Wide-field retinal mosaic image; image size 1924x1556
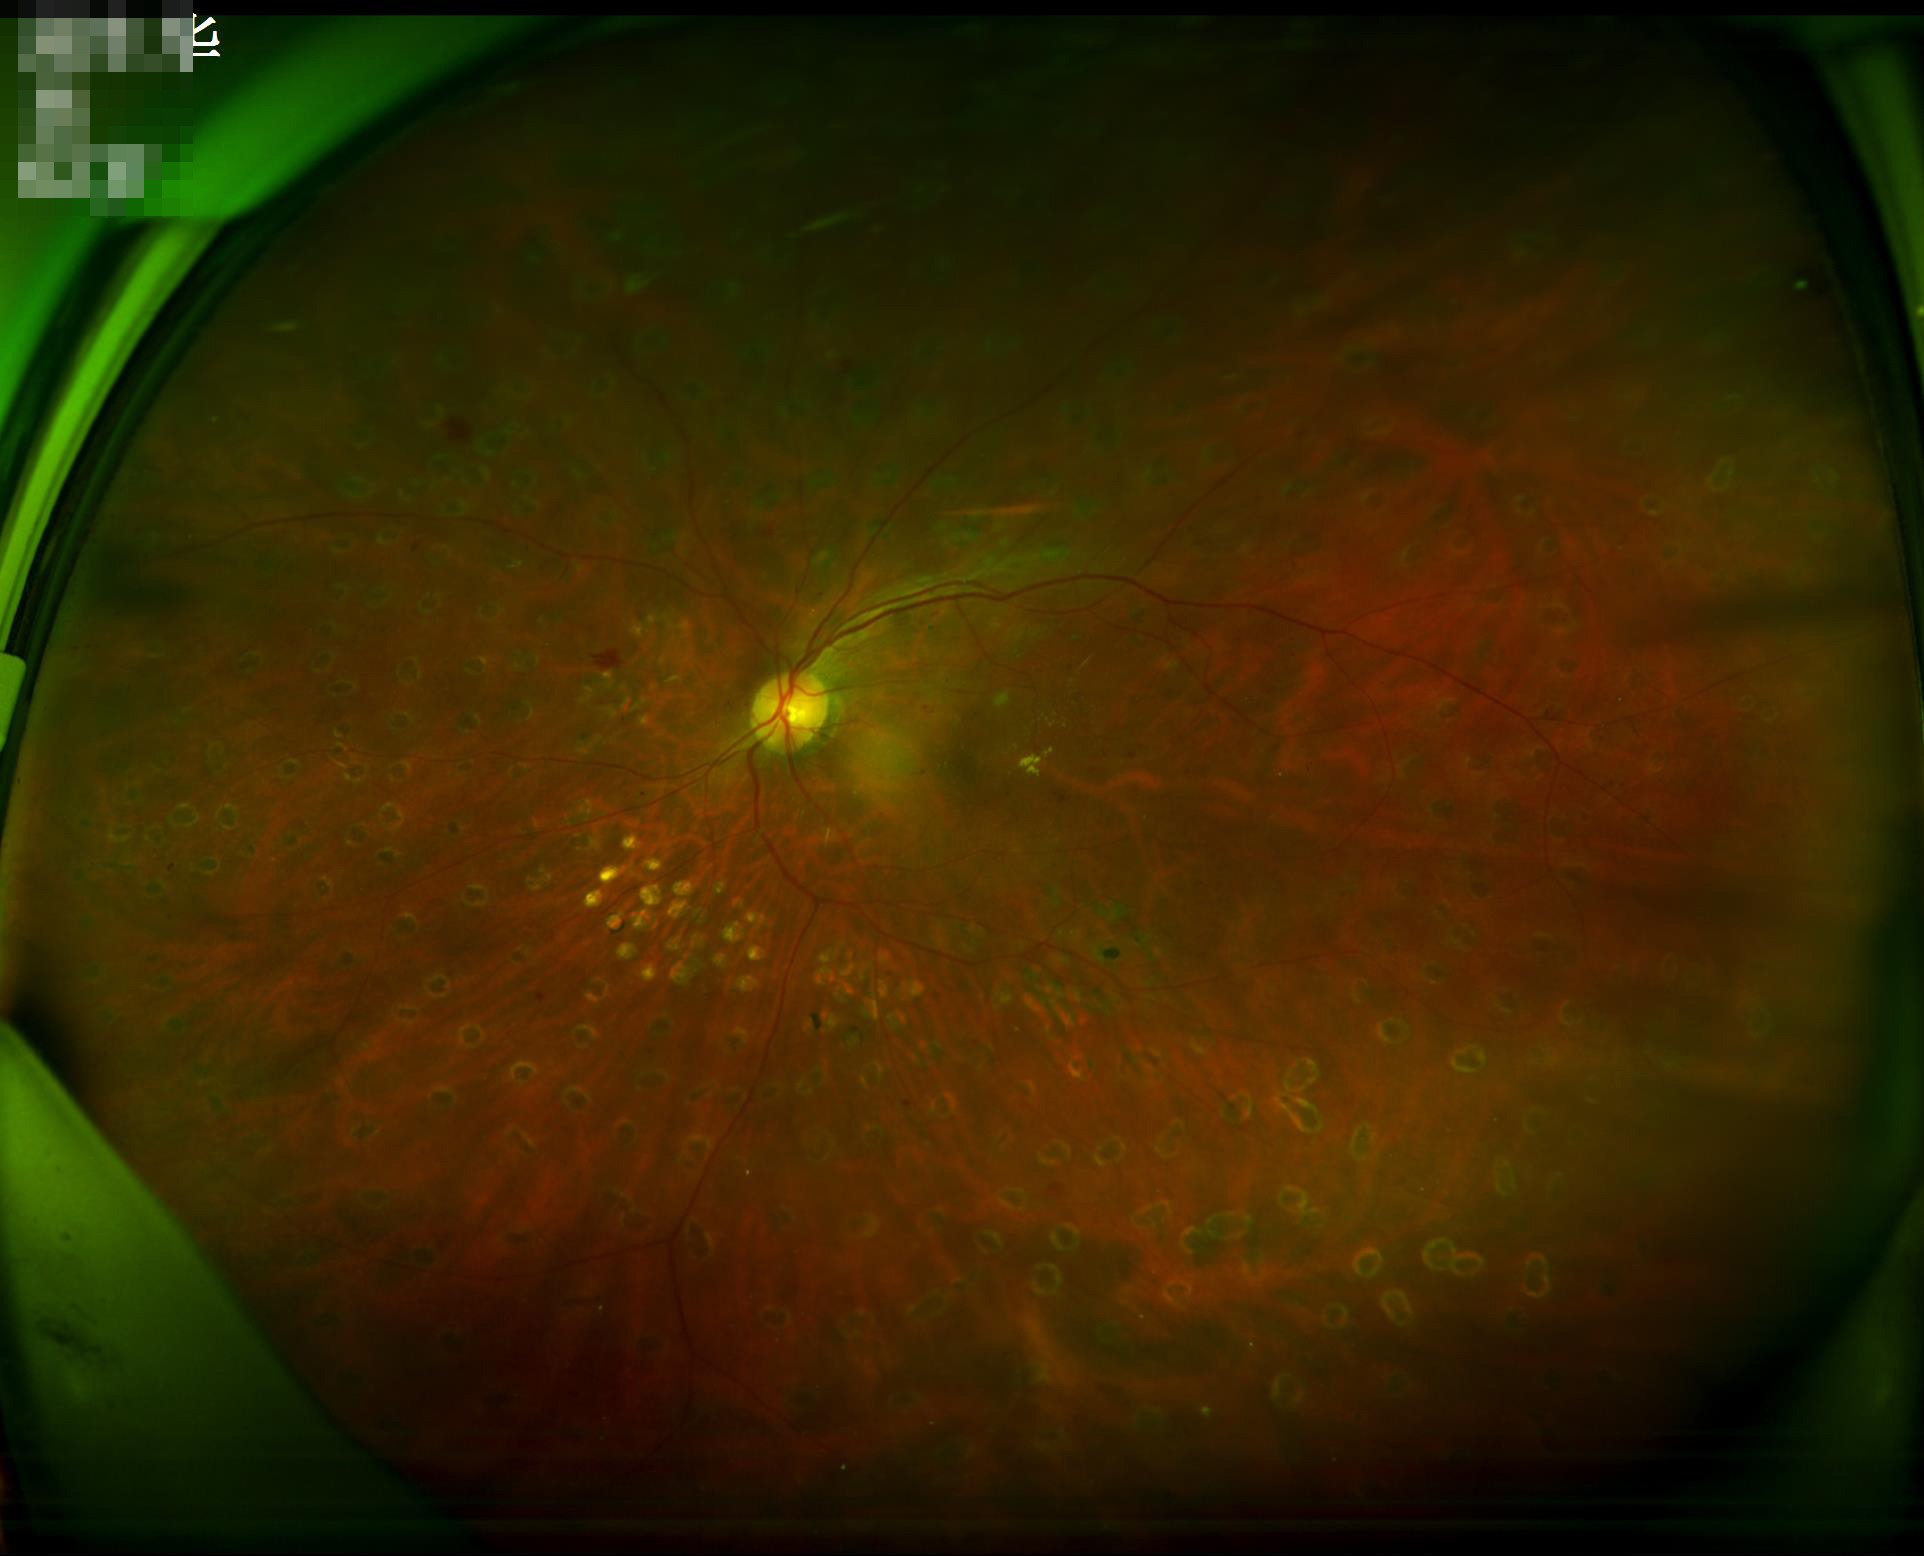
Illumination is uneven. Good dynamic range. Image quality is adequate for diagnostic use.